CFP, 1536x1152, 45° field of view: 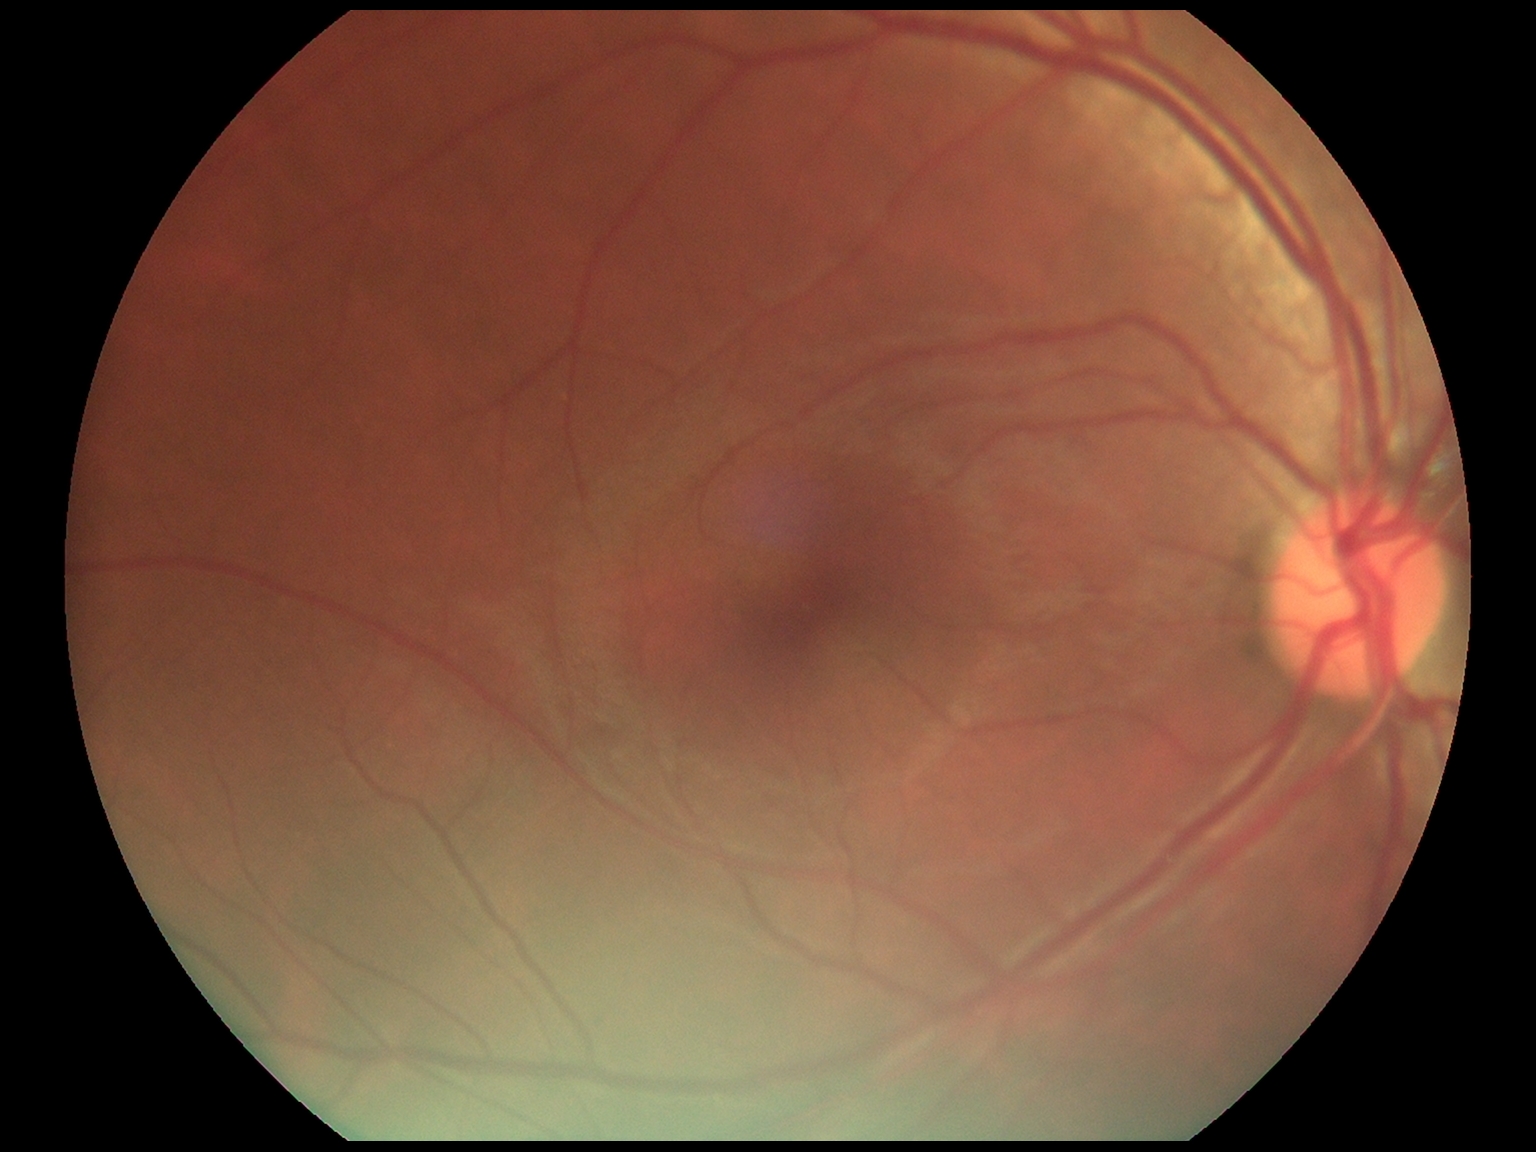
Diabetic retinopathy (DR): grade 0.